2102 x 1736 pixels.
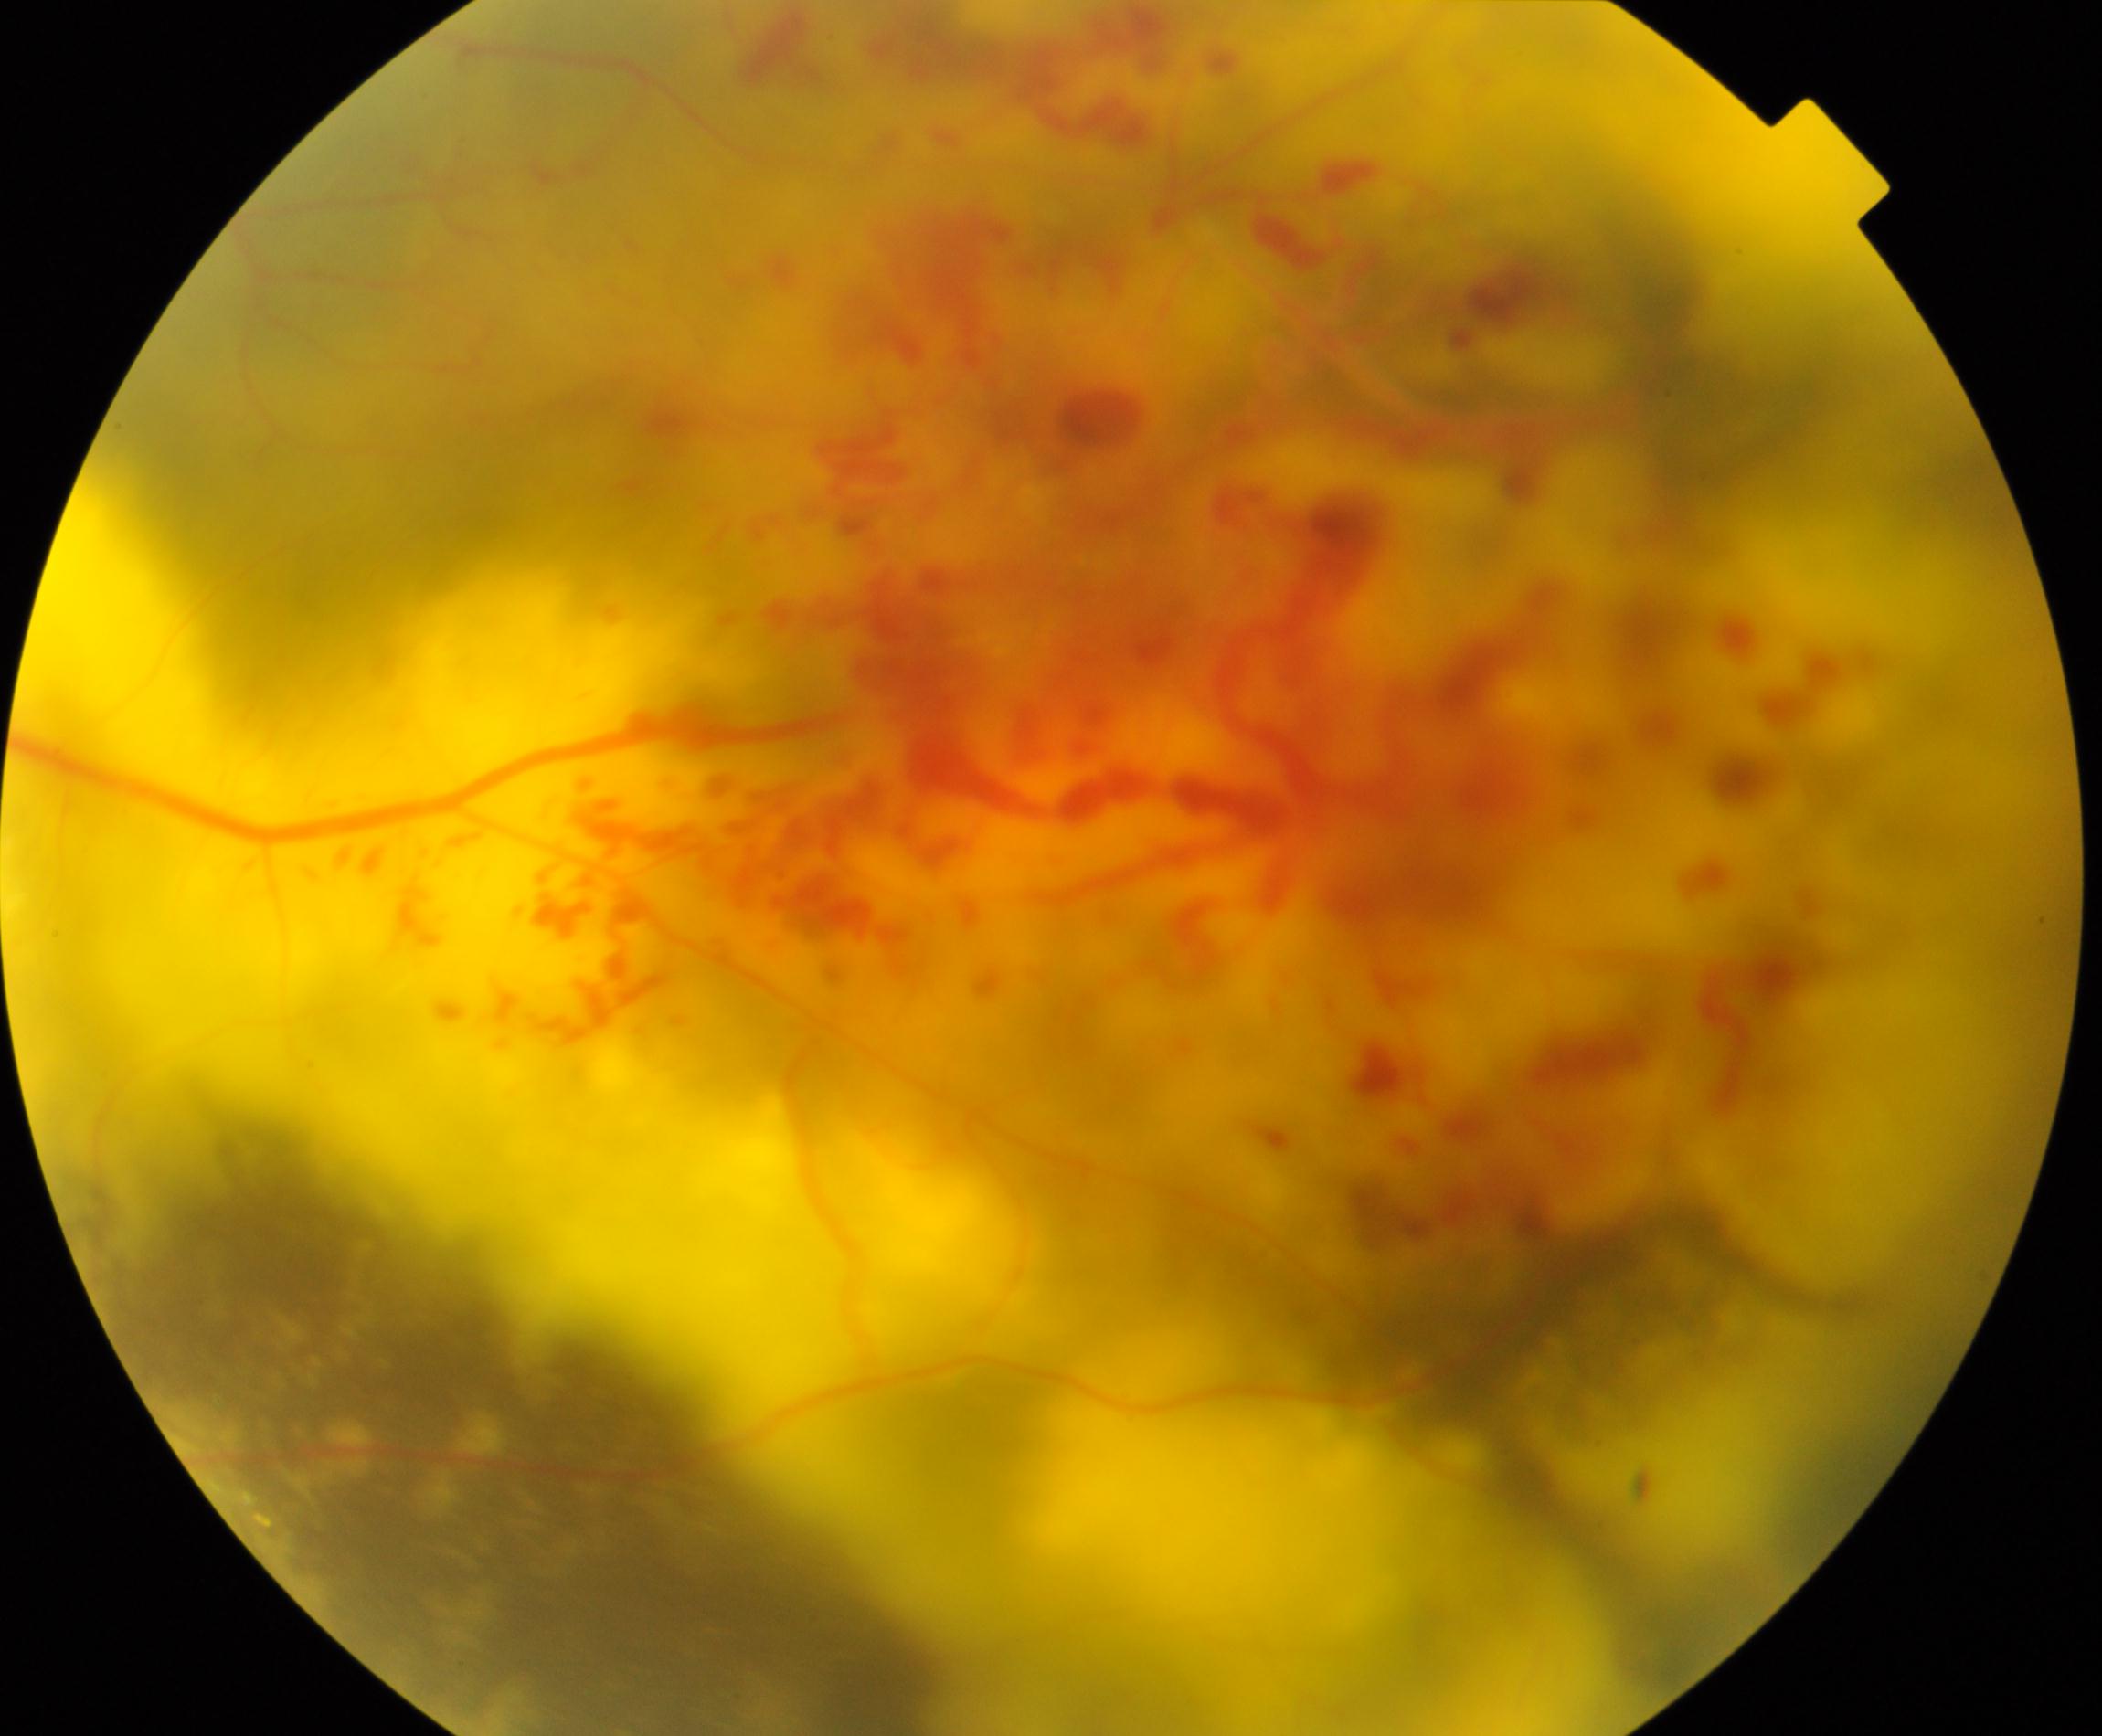

Diagnosis: massive hard exudates.